CFP:
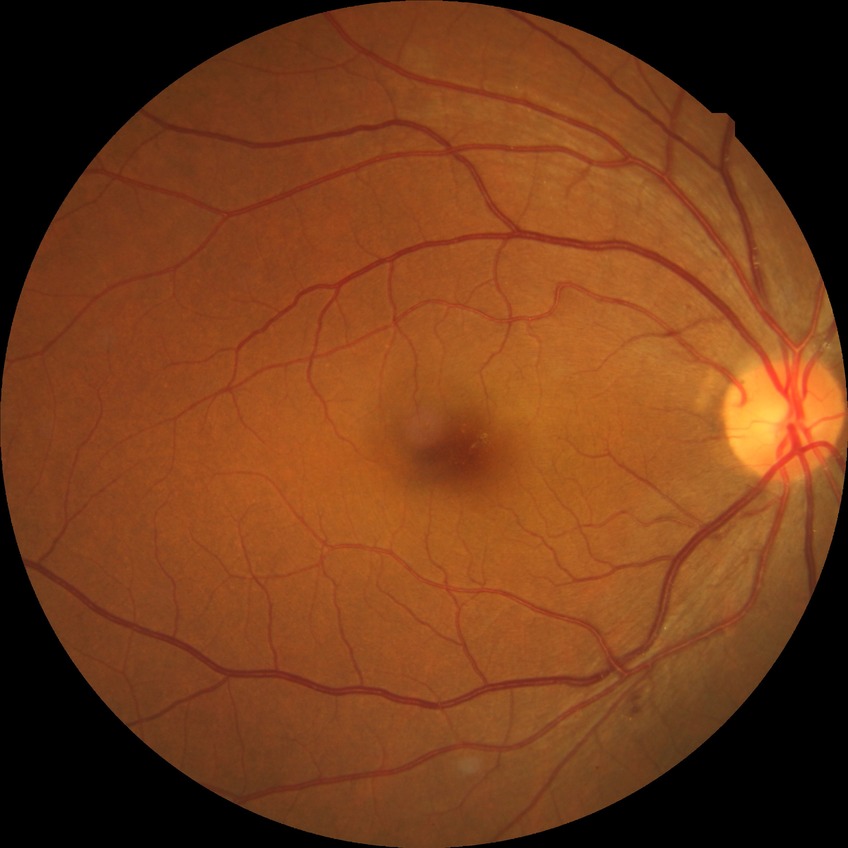 Diabetic retinopathy (DR) is NDR (no diabetic retinopathy).